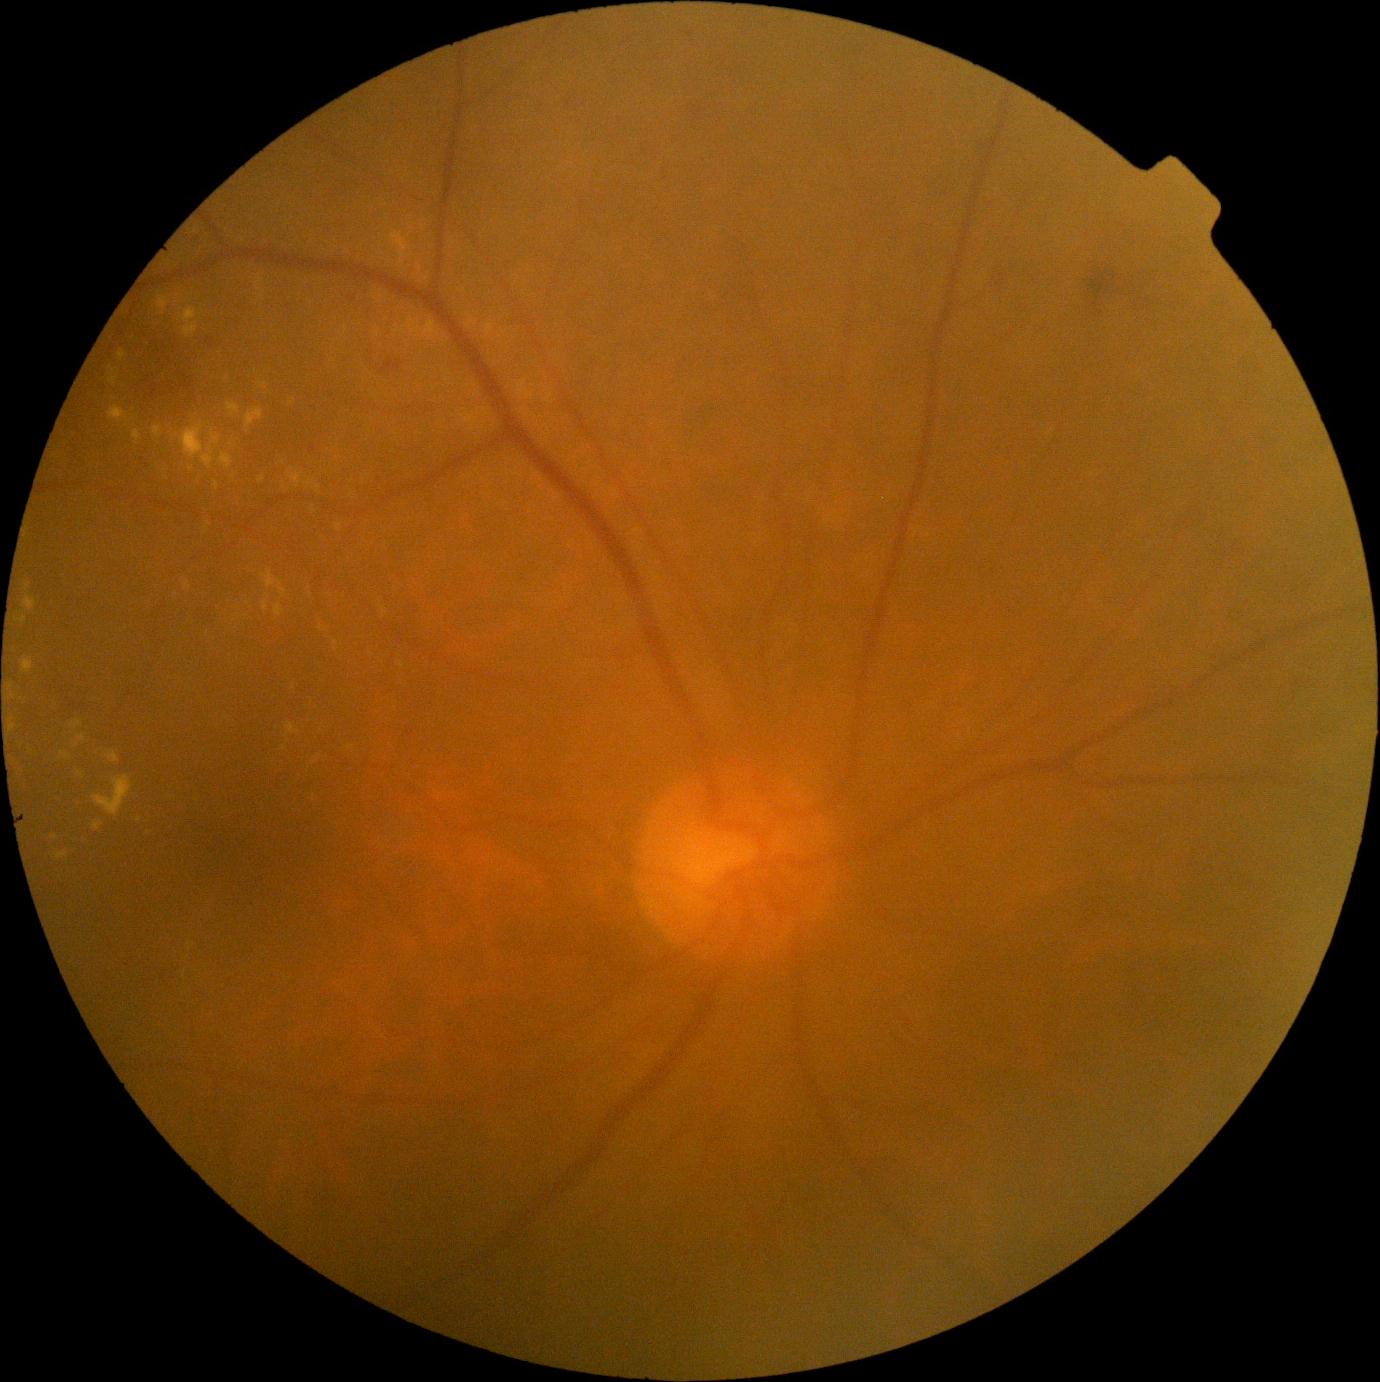

DR grade is 2.